1932 by 1932 pixels. FOV: 50 degrees. Captured after pupil dilation.
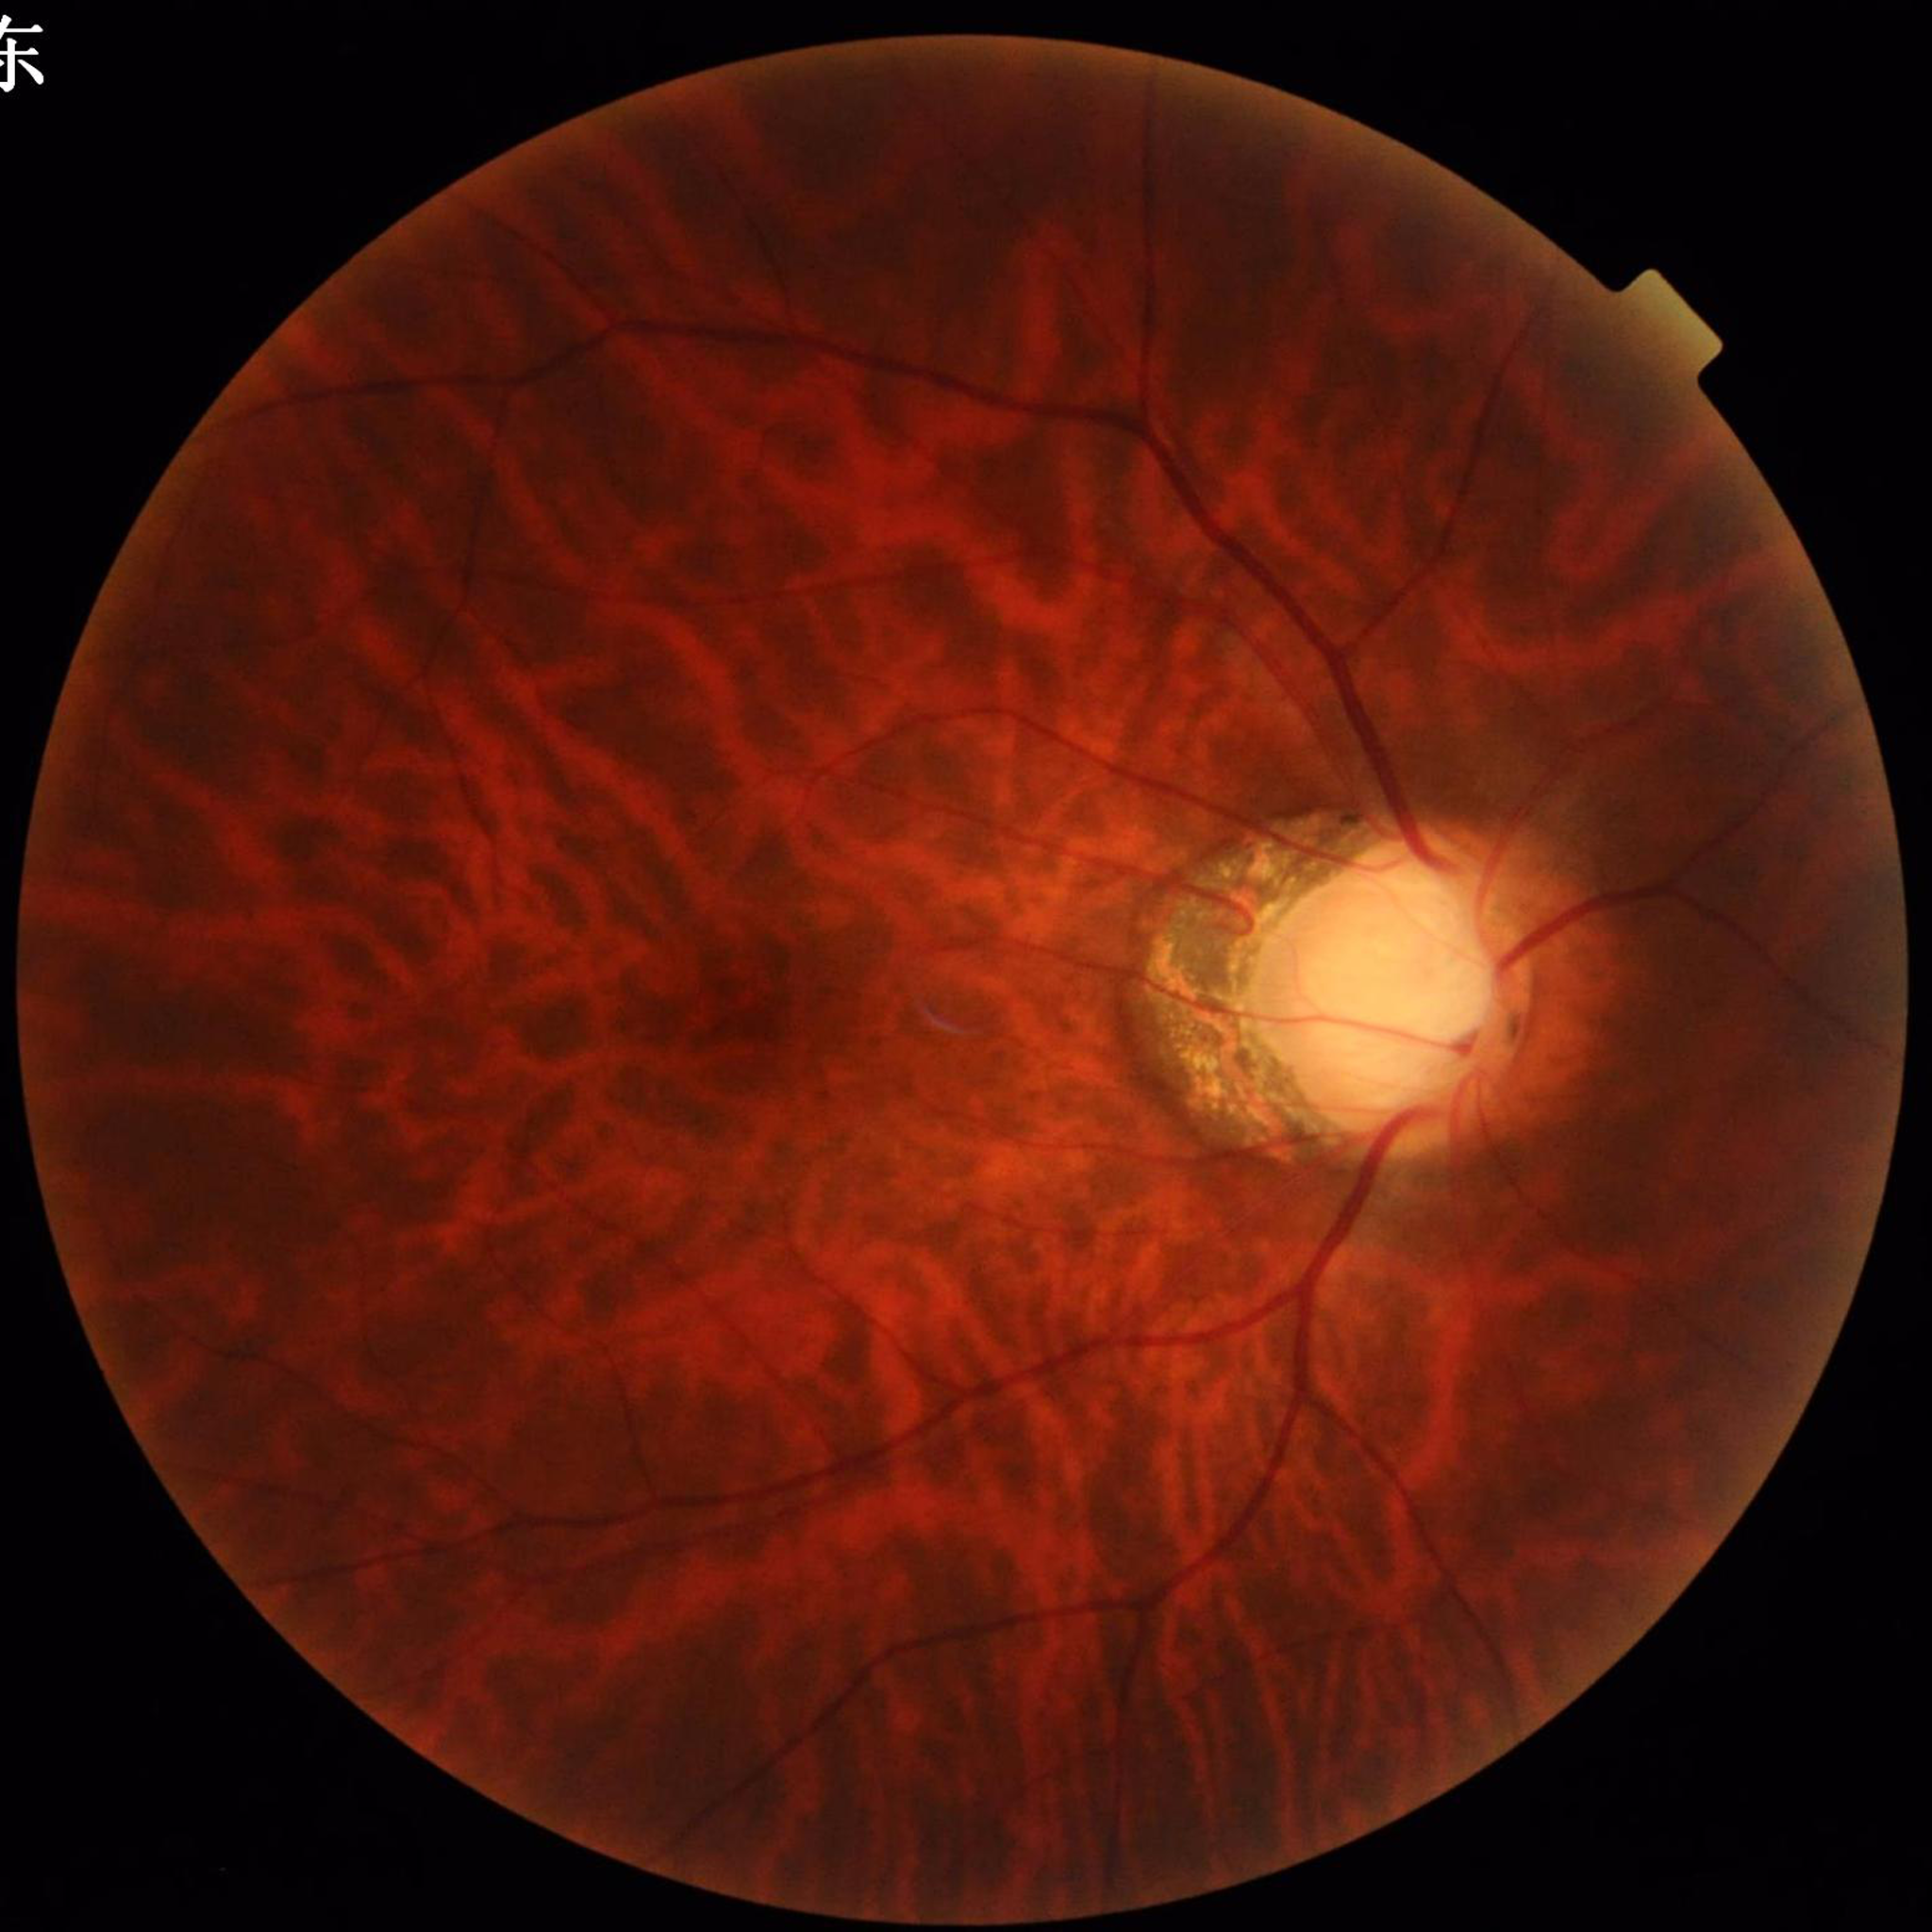
Impression: glaucoma; Quality assessment: satisfactory.